Modified Davis classification:
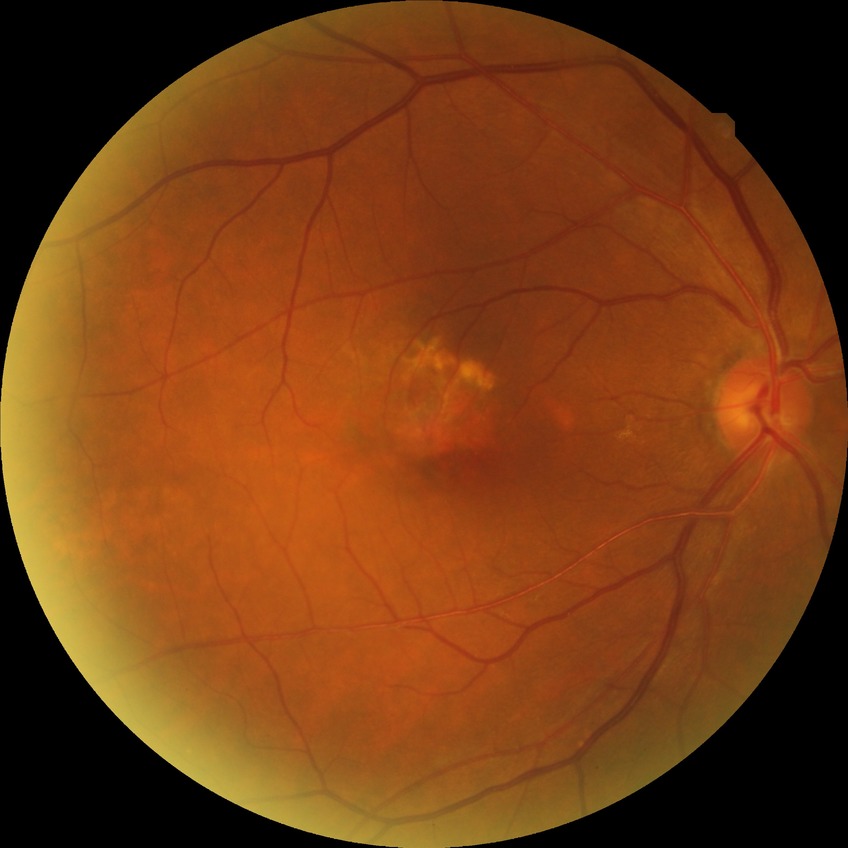
Diabetic retinopathy (DR): NDR (no diabetic retinopathy).